Refractive error: +3.25 -0.75 × 70° · 62-year-old patient · pachymetry 615 µm · undilated pupil · perimetry mean defect: -23.31 dB · captured on a Topcon TRC-NW400 fundus camera · woman · intraocular pressure (IOP): 22 mmHg · 2212 by 1661 pixels
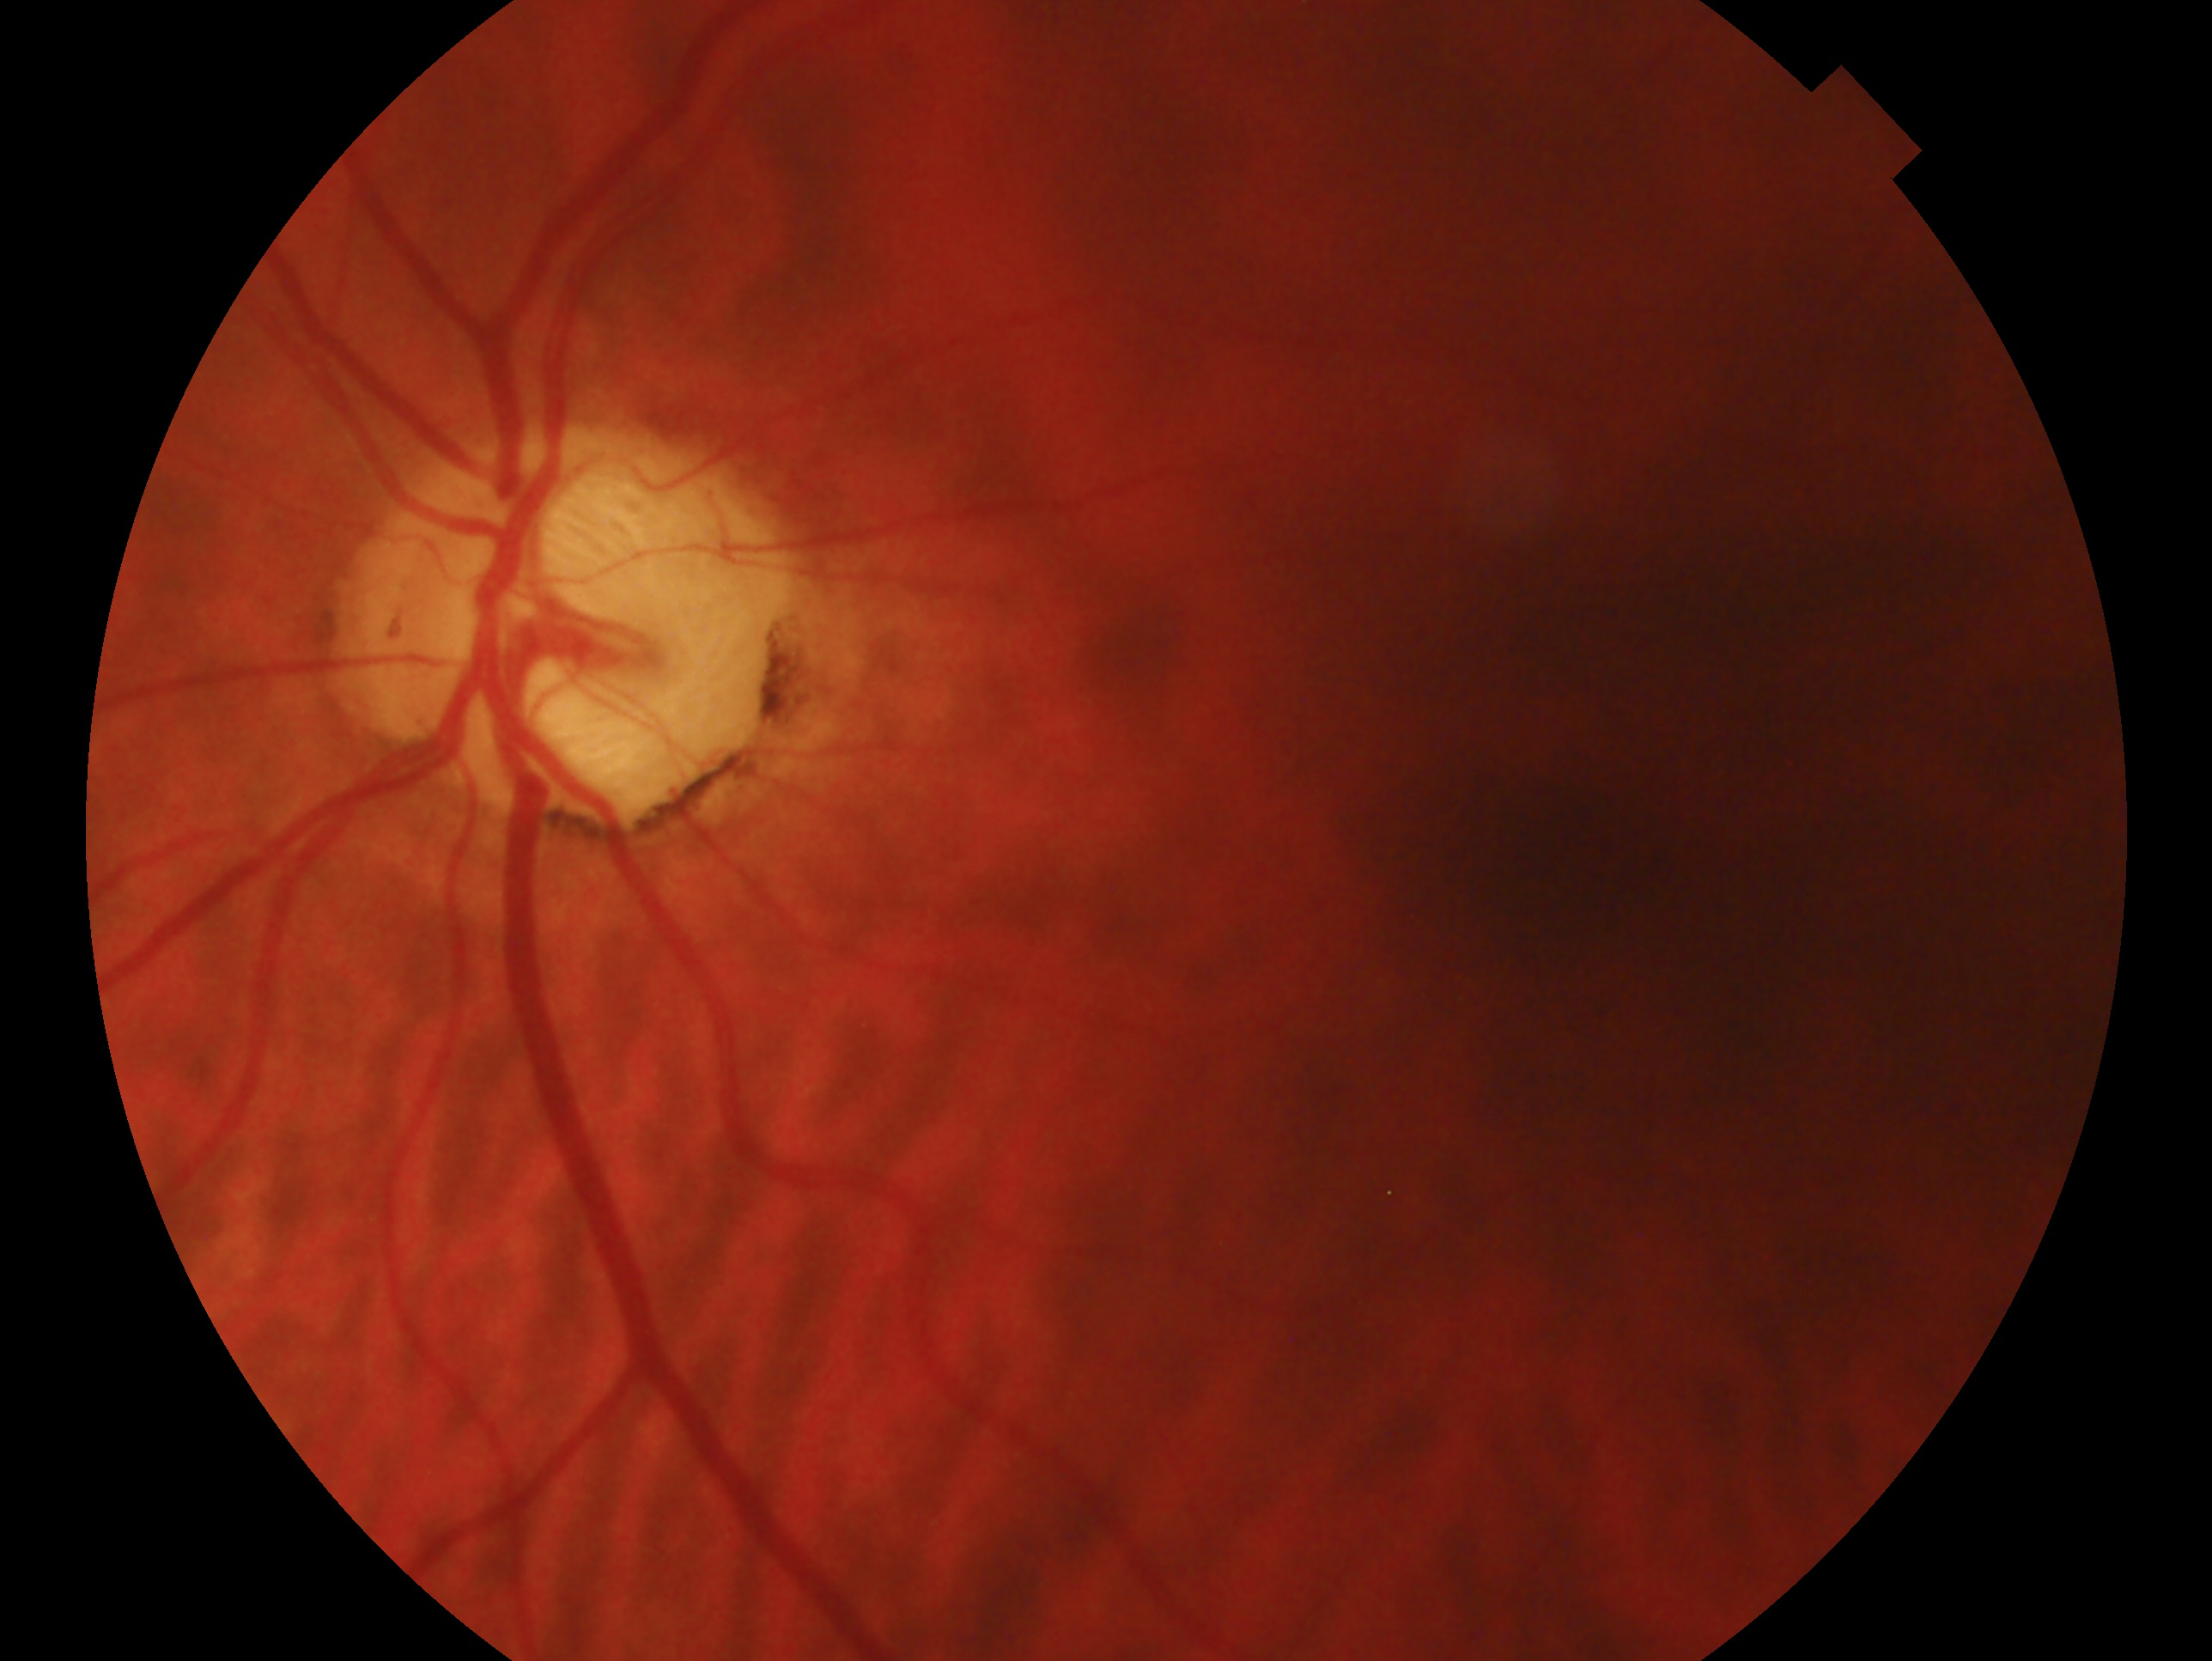

eye=OS | diagnosis=consistent with glaucoma.